NIDEK AFC-230 fundus camera · 45° FOV · CFP · modified Davis classification · 848 x 848 pixels.
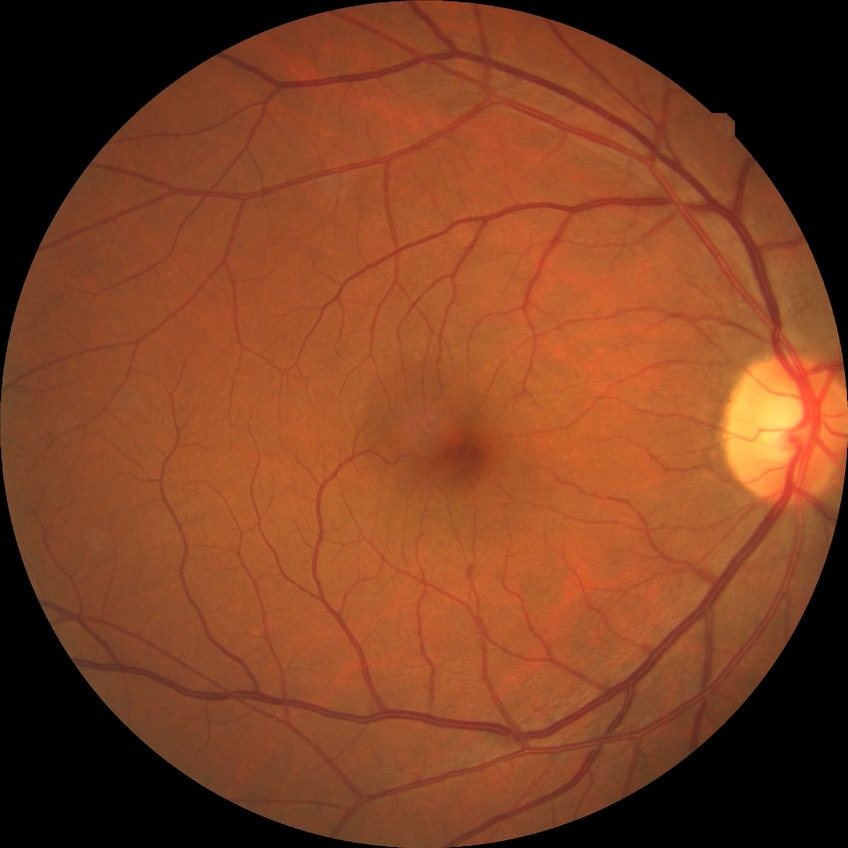

Modified Davis grade is NDR.